NIDEK AFC-230 fundus camera.
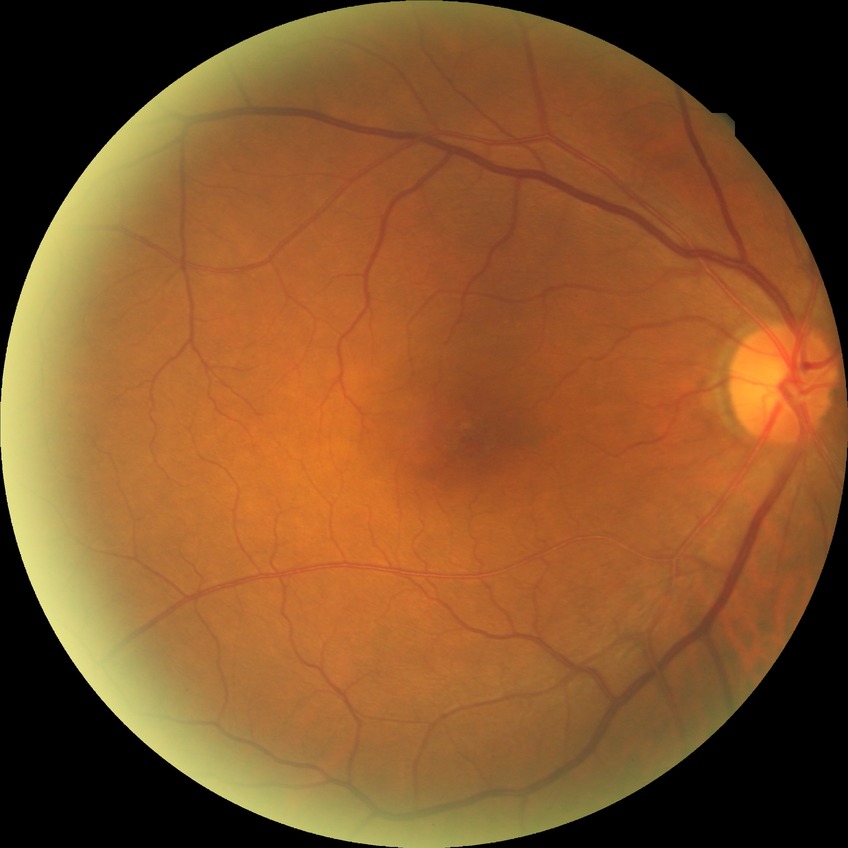
{
  "davis_grade": "NDR"
}